2228 x 1652 pixels, CFP, camera: Topcon TRC-50DX, posterior pole view, FOV: 50 degrees — 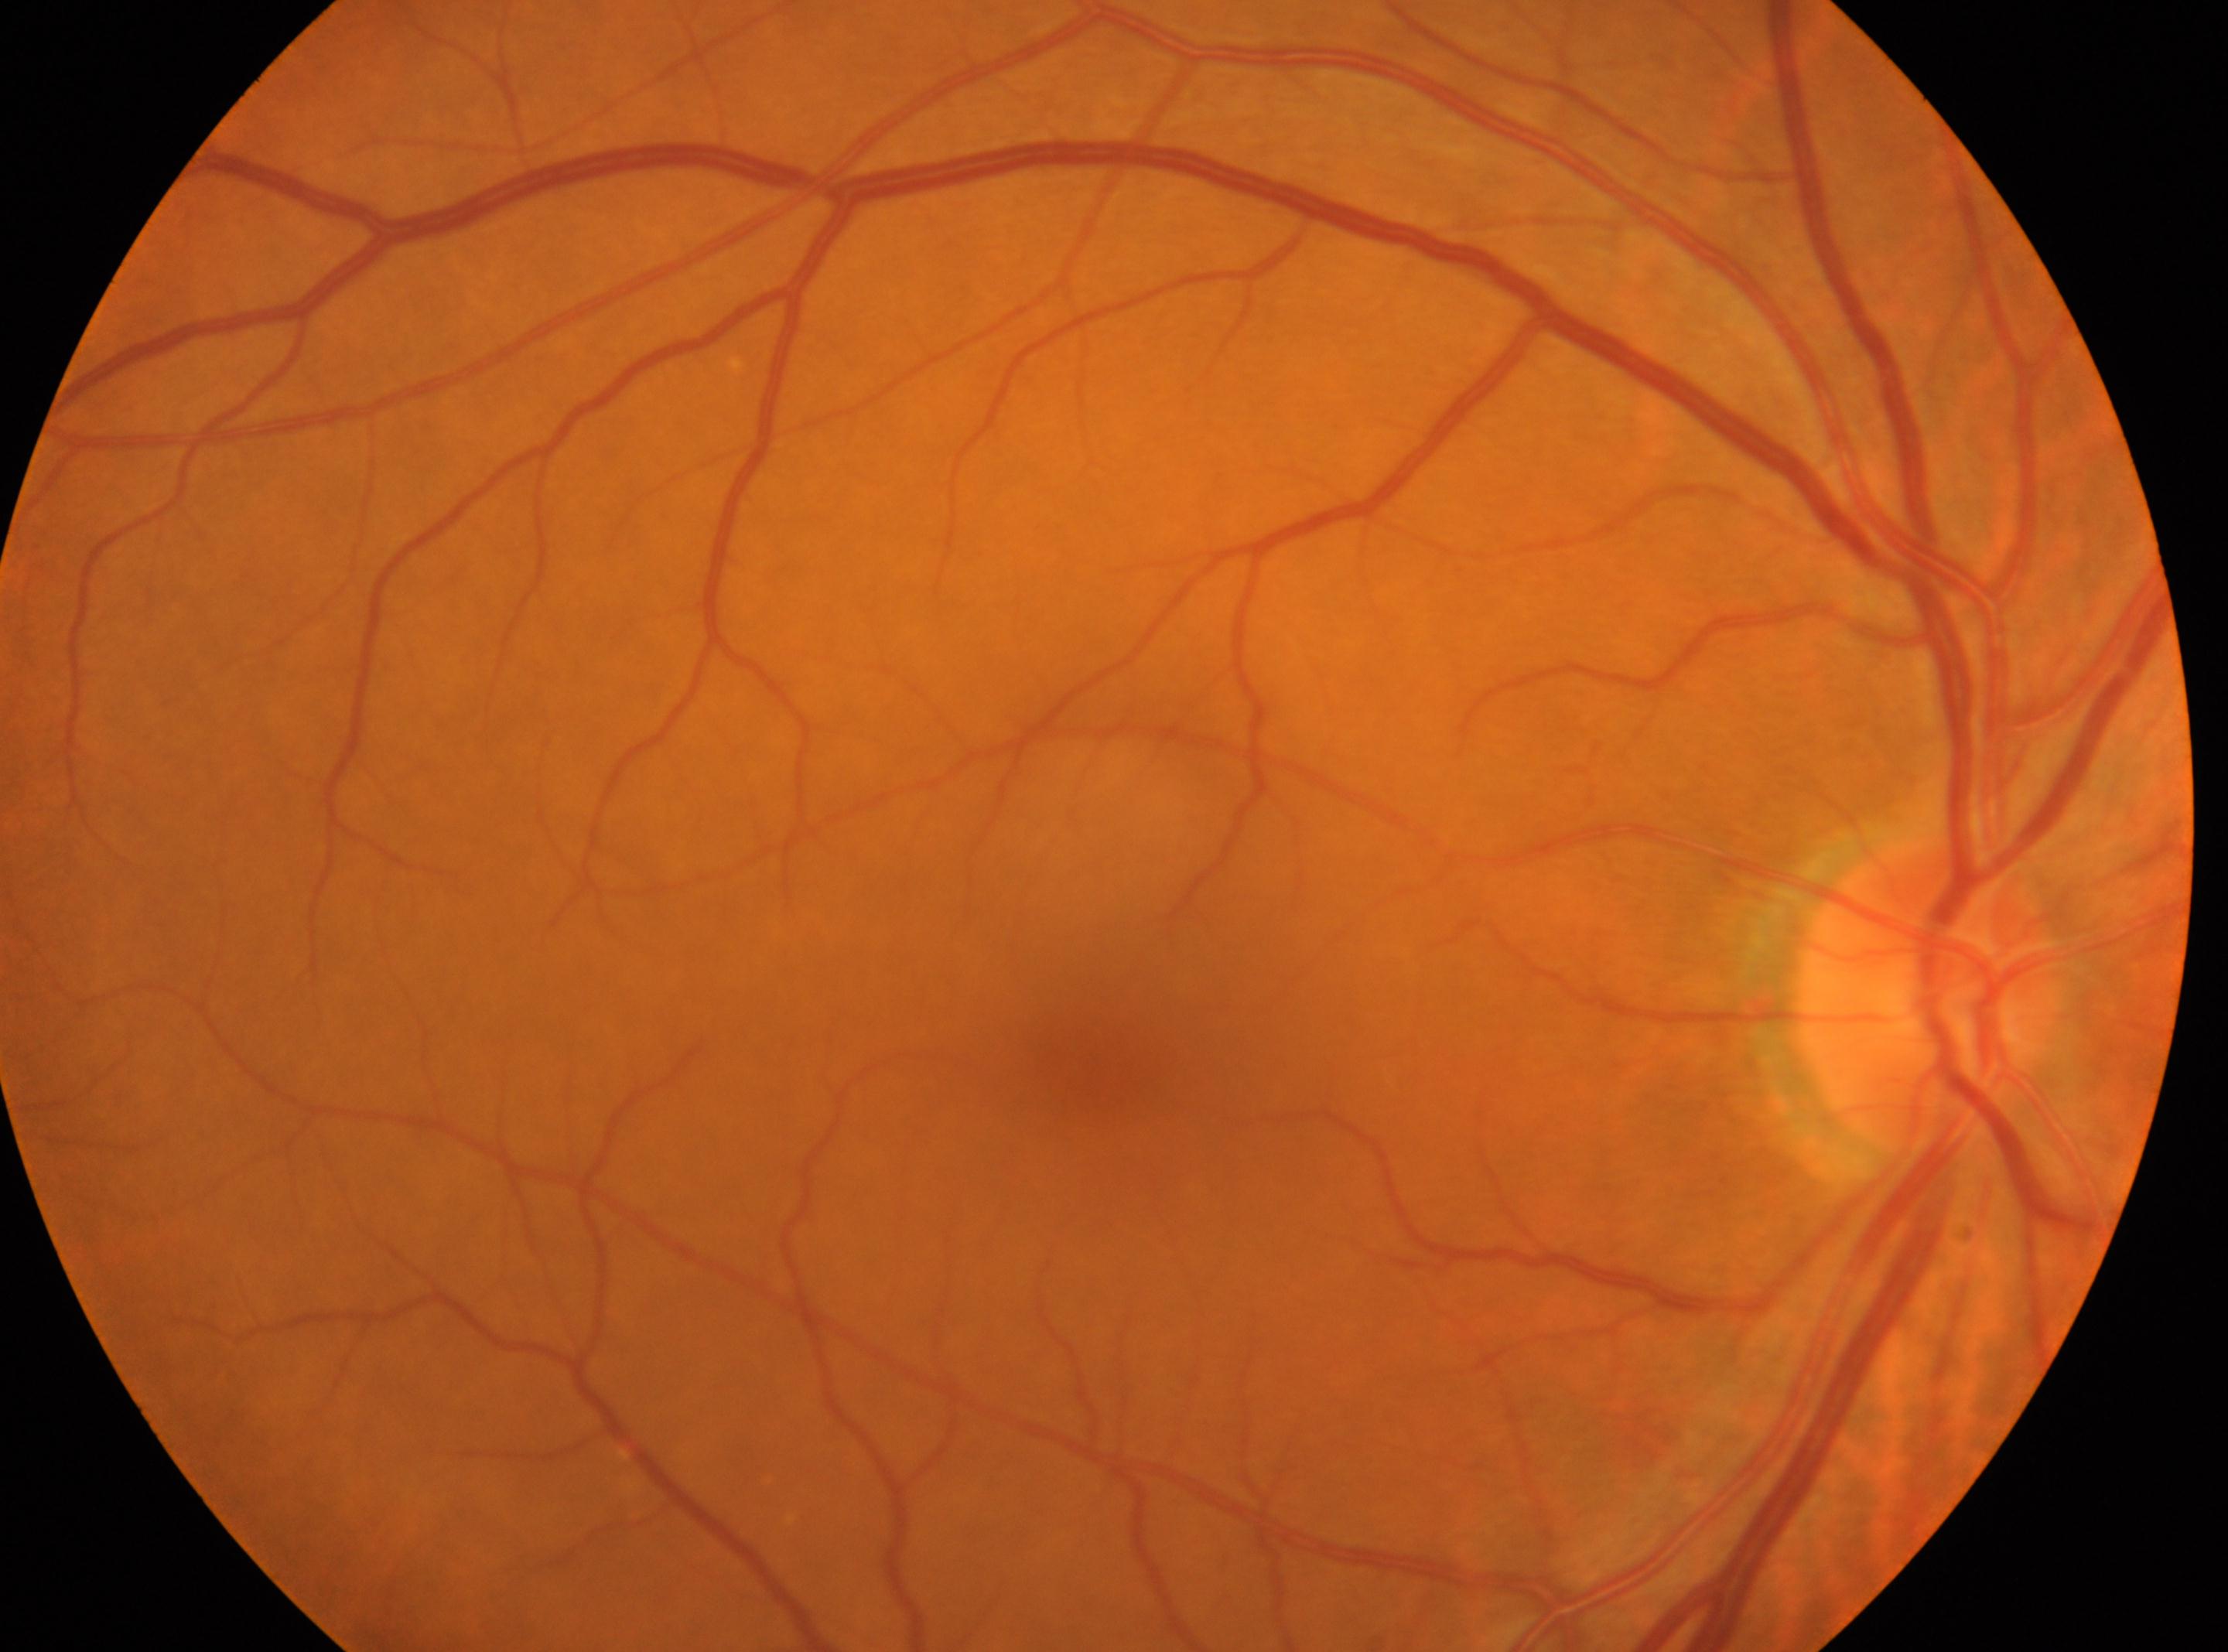
* ONH — x=1924, y=998
* eye — OD
* DR — grade 0 (no apparent retinopathy)
* DR impression — No diabetic retinal disease findings
* macular center — x=1094, y=1067